50° field of view · retinal fundus photograph: 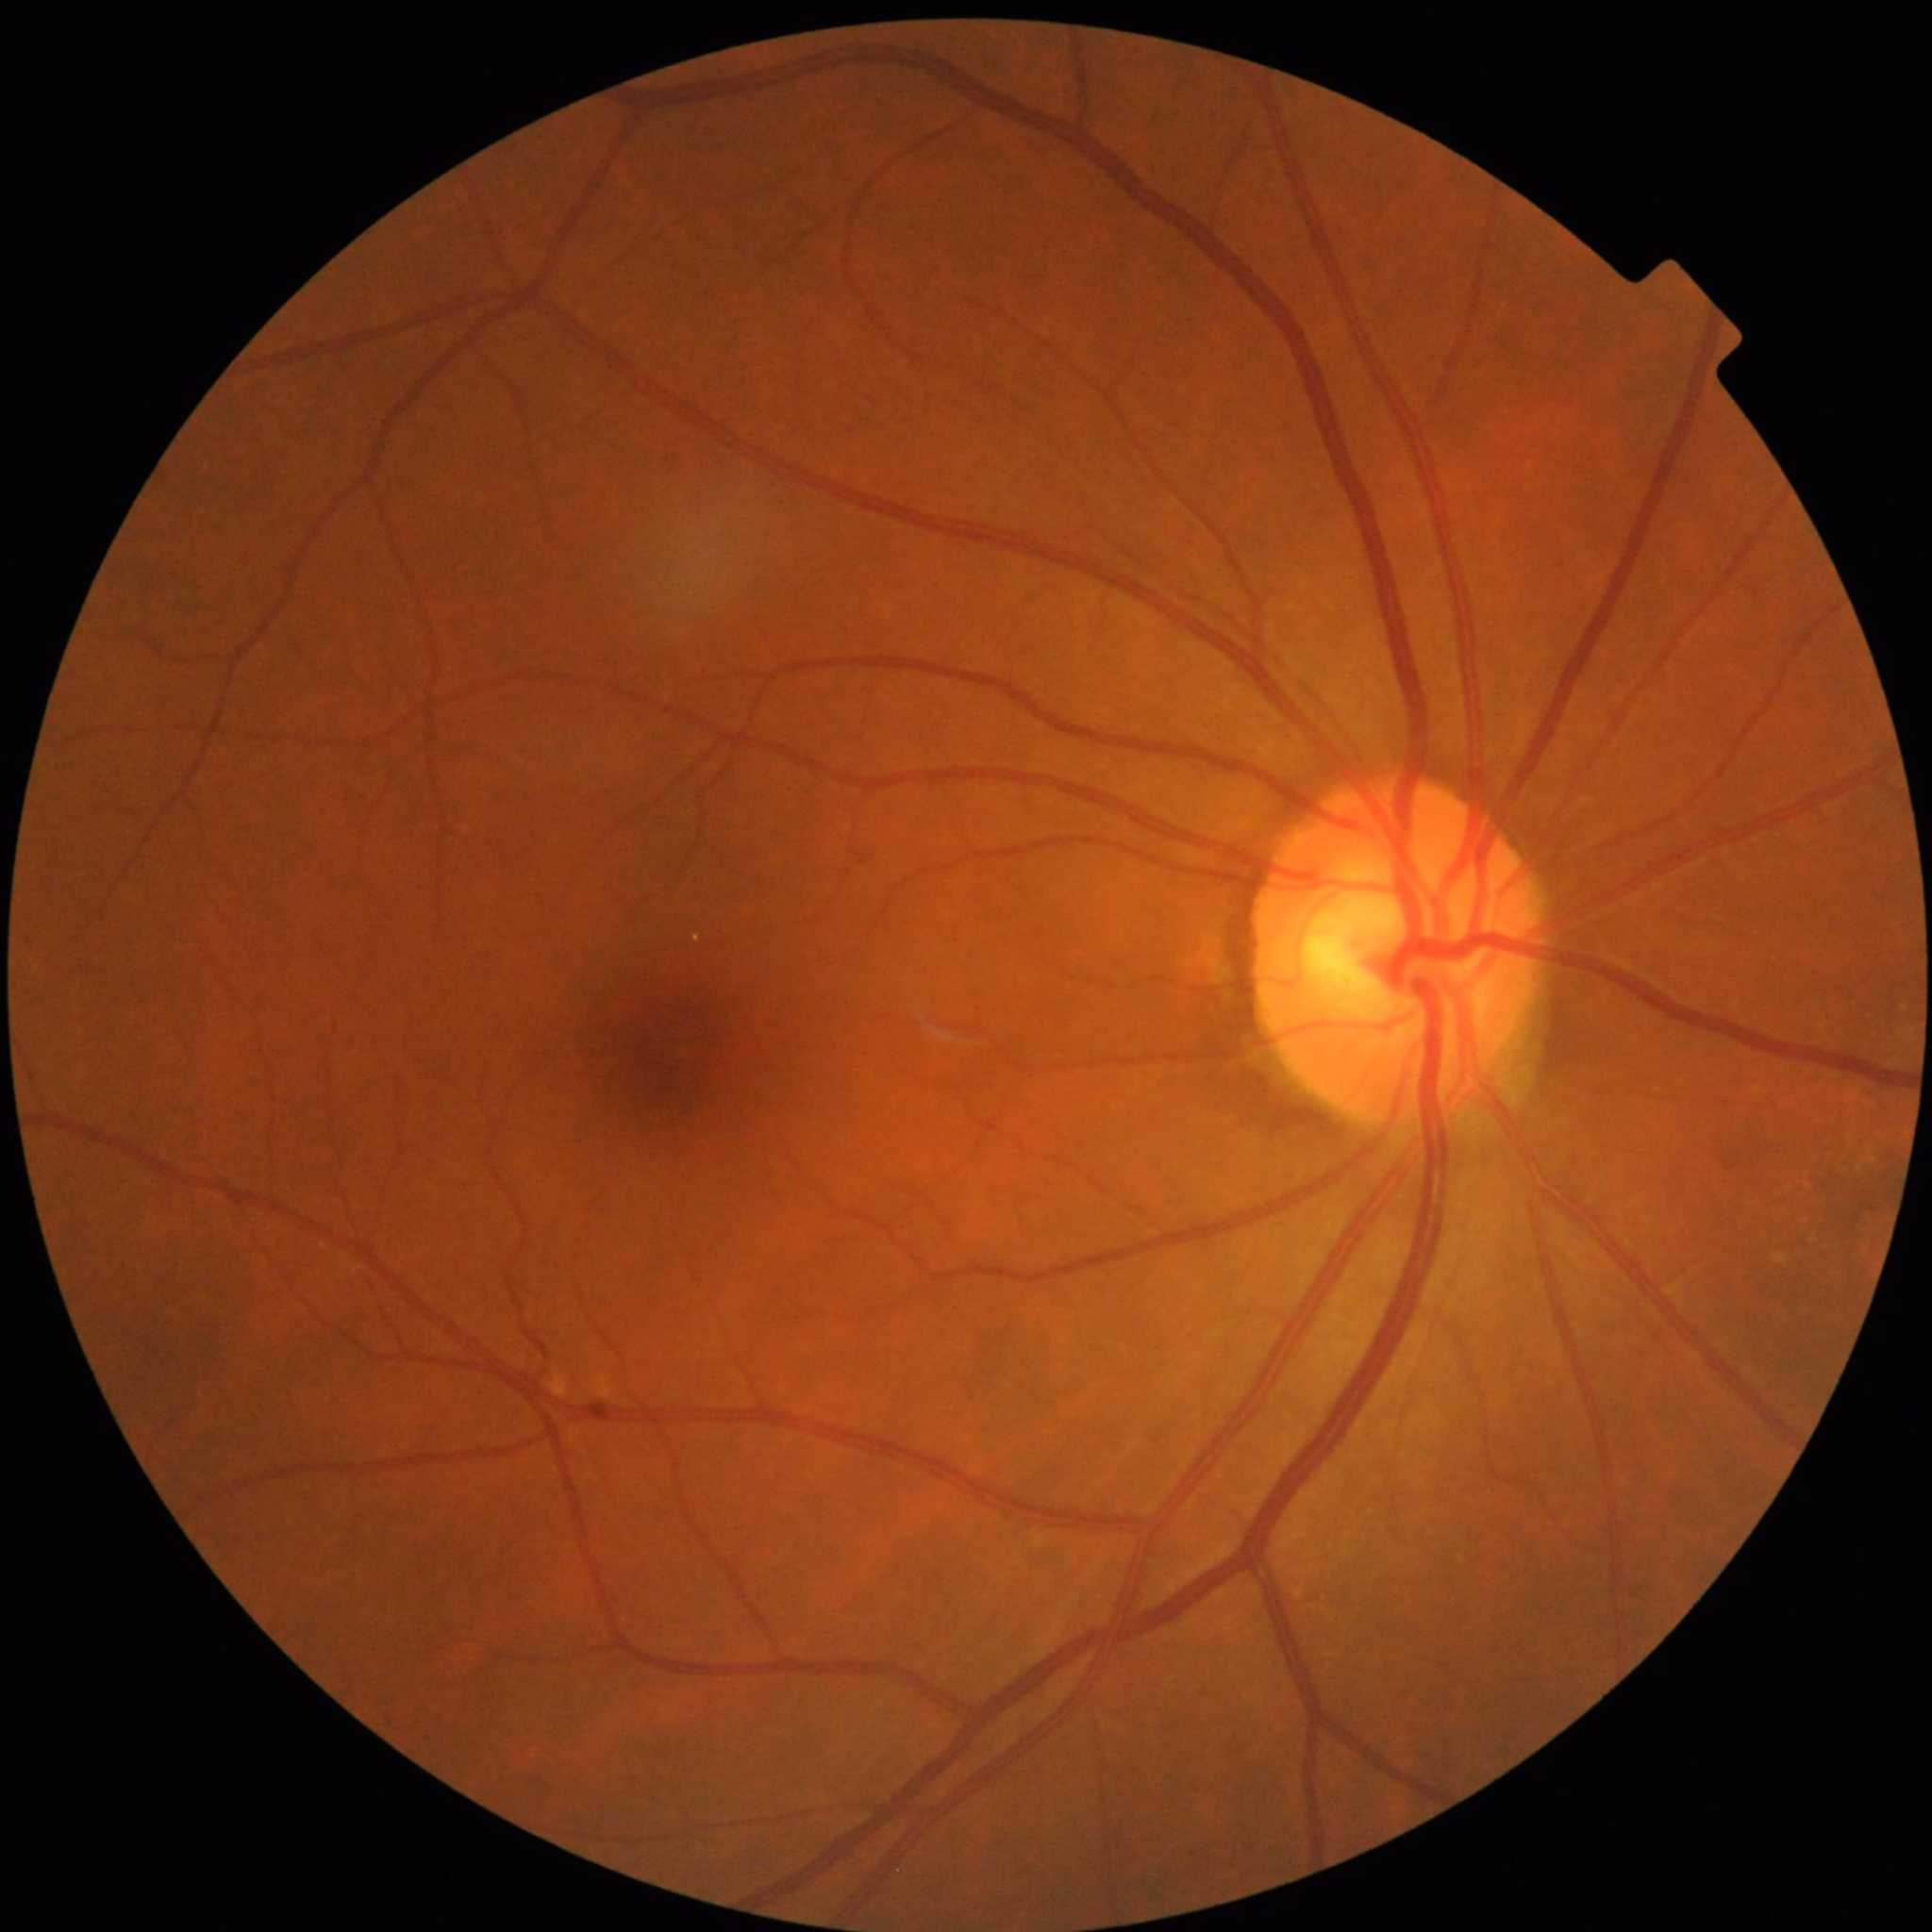
Clinical diagnosis = control (no AMD/DR/glaucoma)